Color fundus photograph from a handheld portable camera: 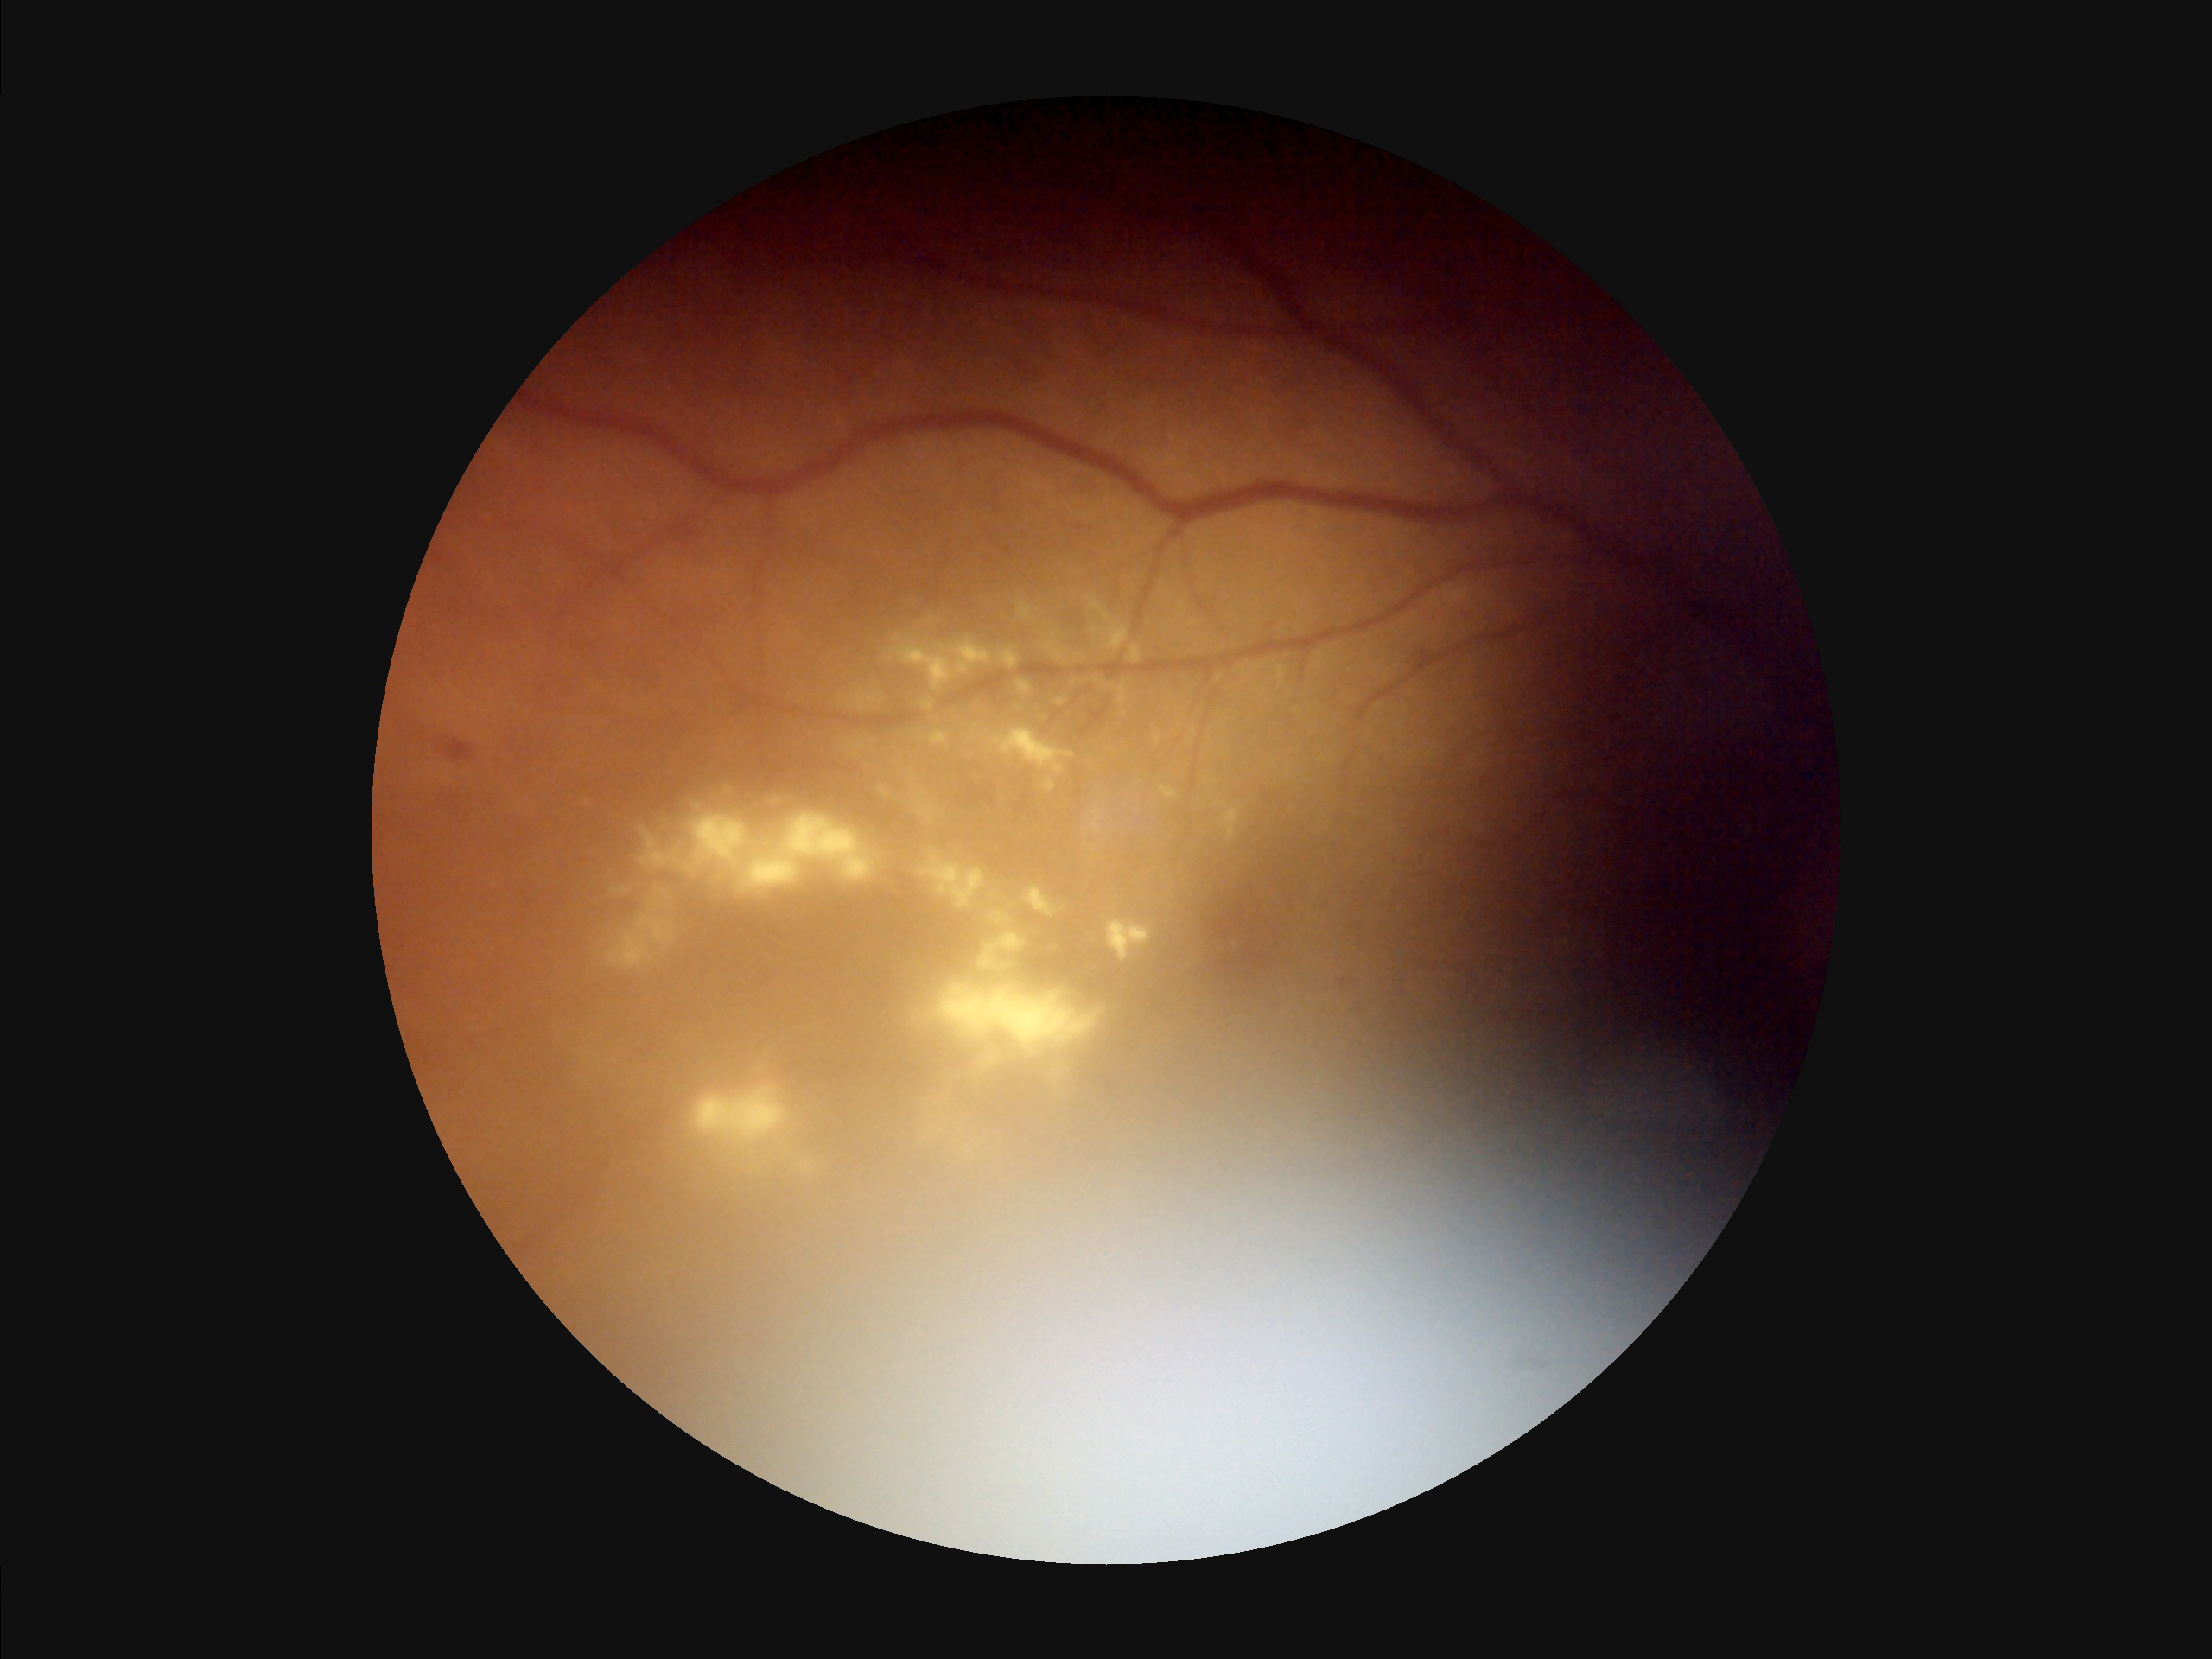

Vessels and details are hard to distinguish. Noticeable blur in the optic disc, vessels, or background. Poor illumination with uneven exposure. Image quality is suboptimal.